Acquired with a NIDEK AFC-230 · image size 848x848 · nonmydriatic fundus photograph · 45° FOV · Davis DR grading
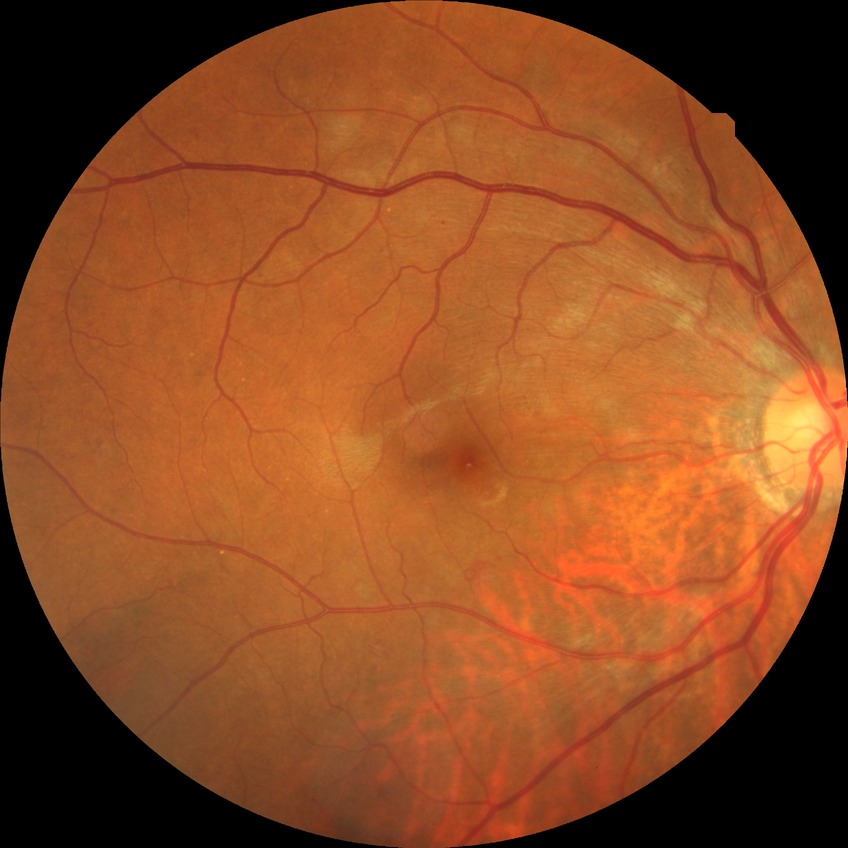 Diabetic retinopathy stage is simple diabetic retinopathy.